Captured on a Topcon TRC-50DX fundus camera, field includes the optic disc and macula, fundus photo, captured after pupil dilation.
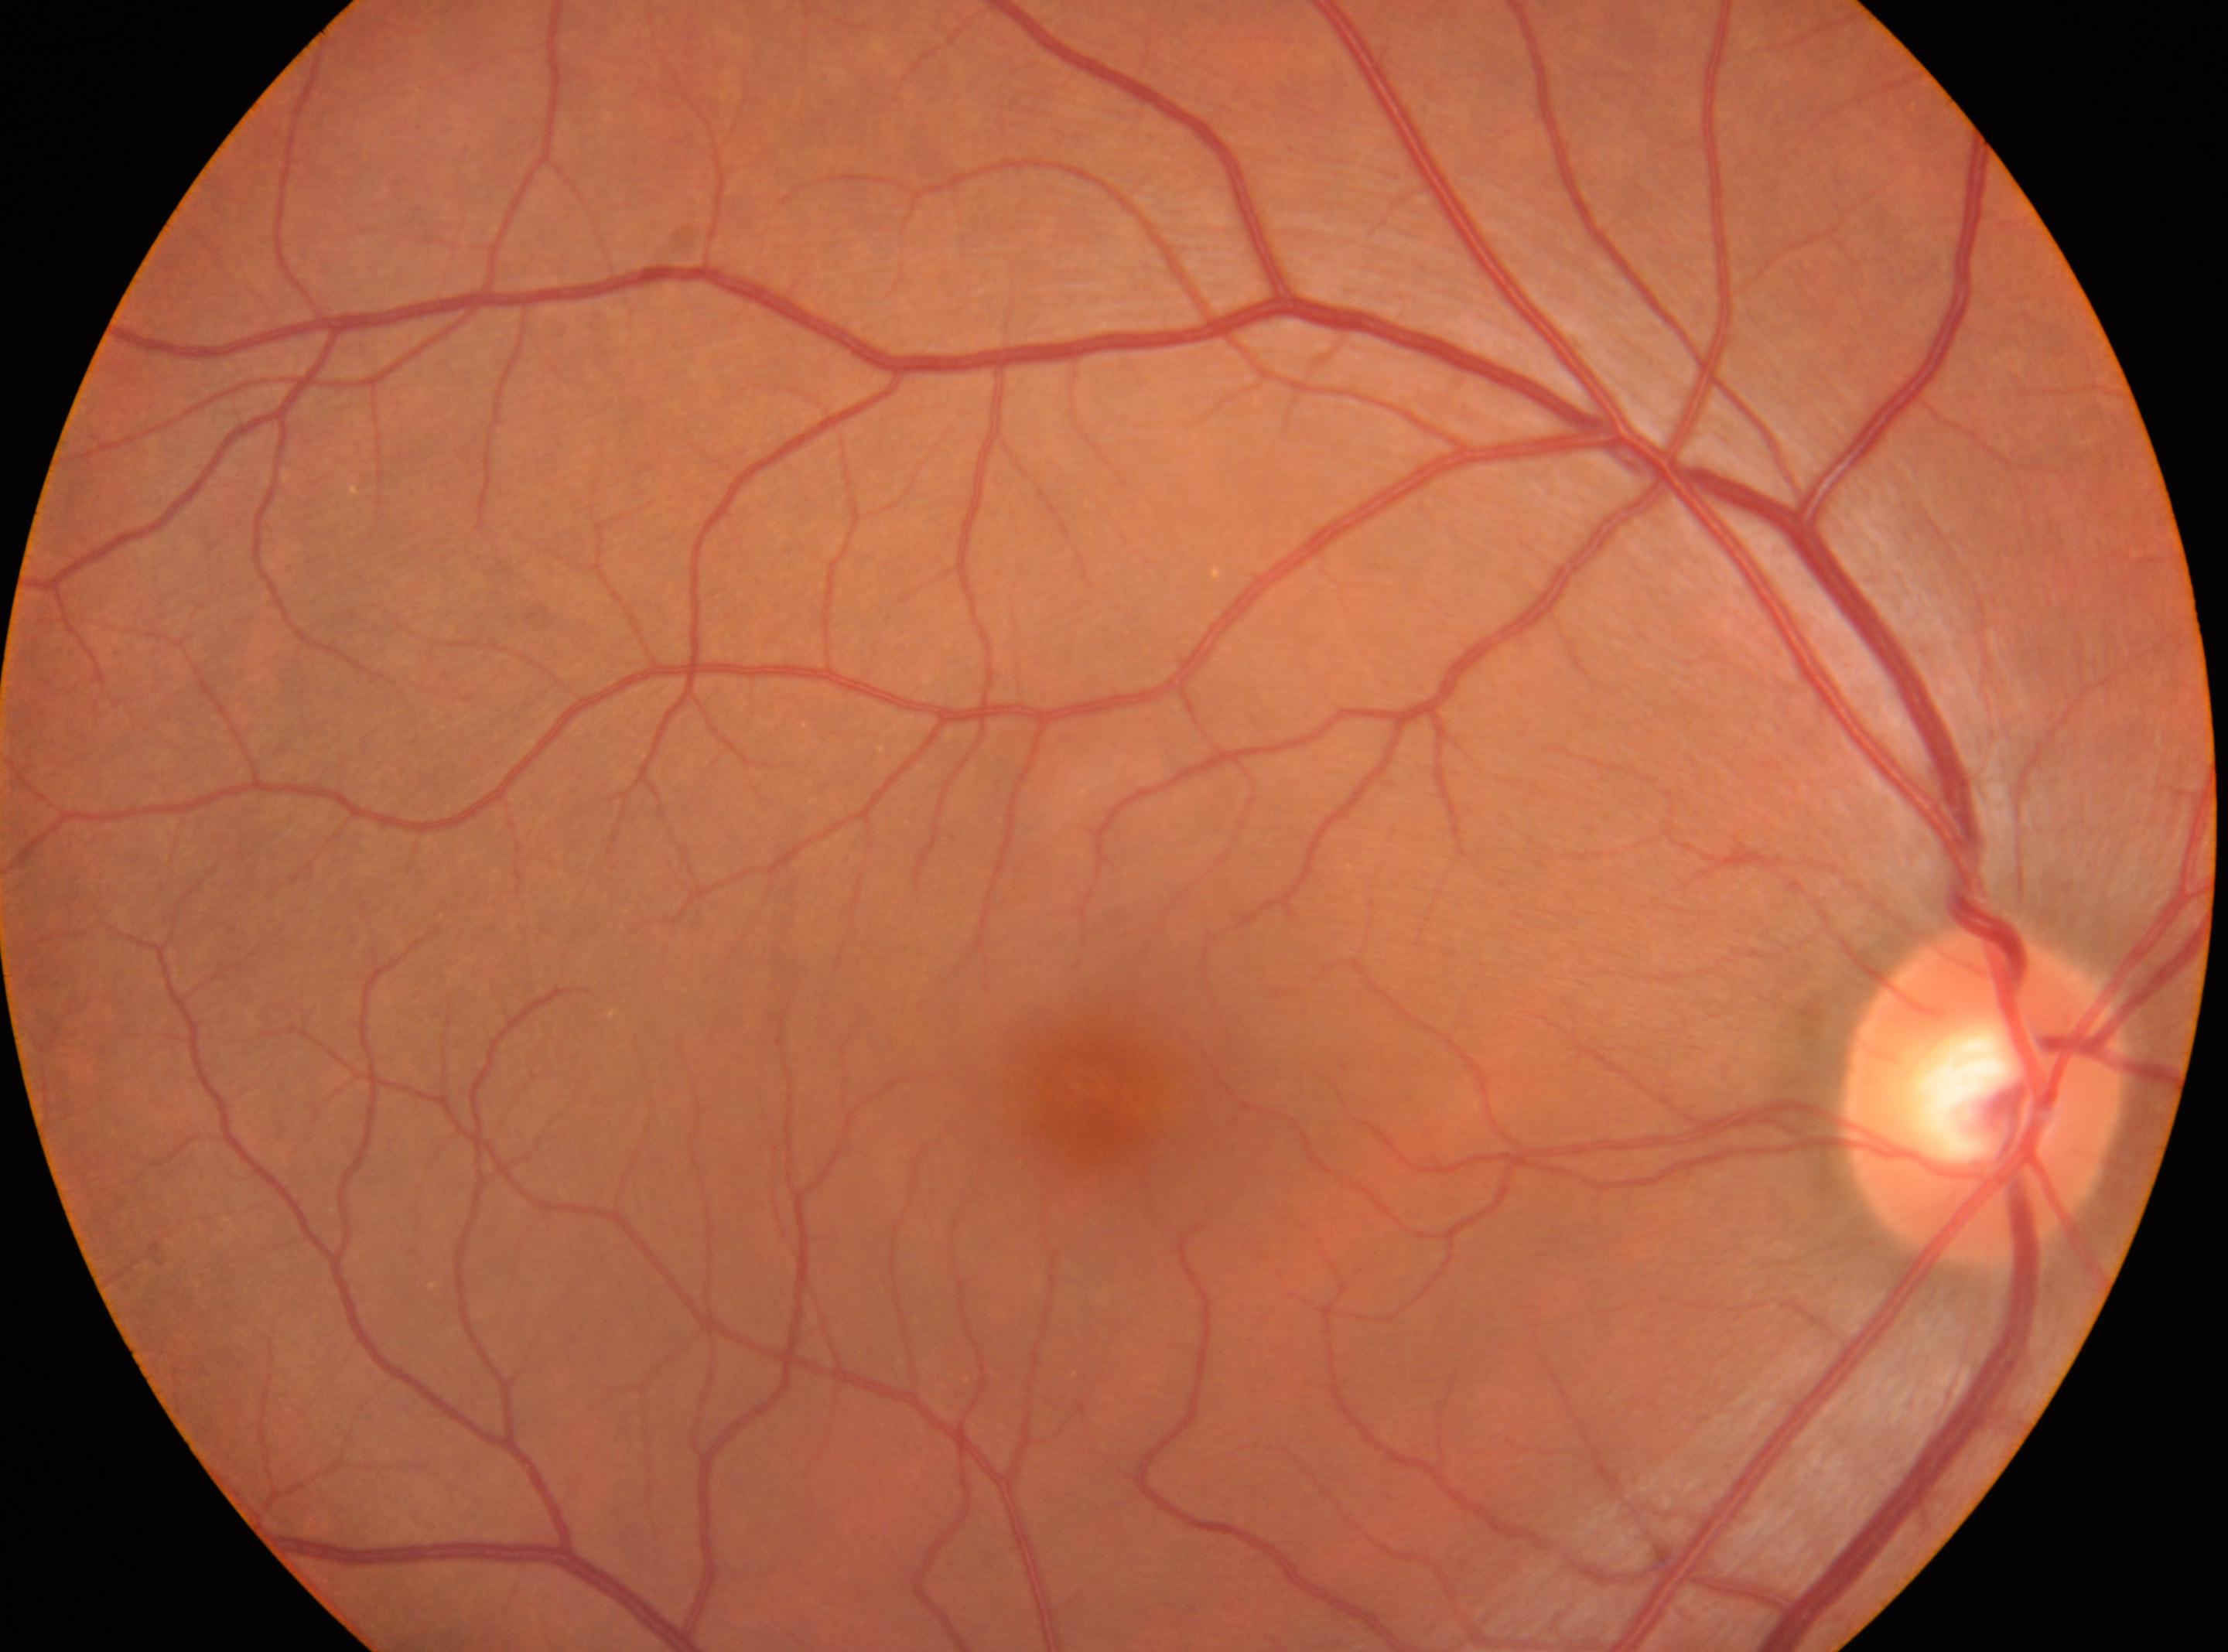
Optic disc center: 1984, 1094. Eye: OD. The foveal center is at 1088, 1083. No apparent diabetic retinopathy. Diabetic retinopathy grade is 0/4.